640 by 480 pixels. Infant wide-field fundus photograph:
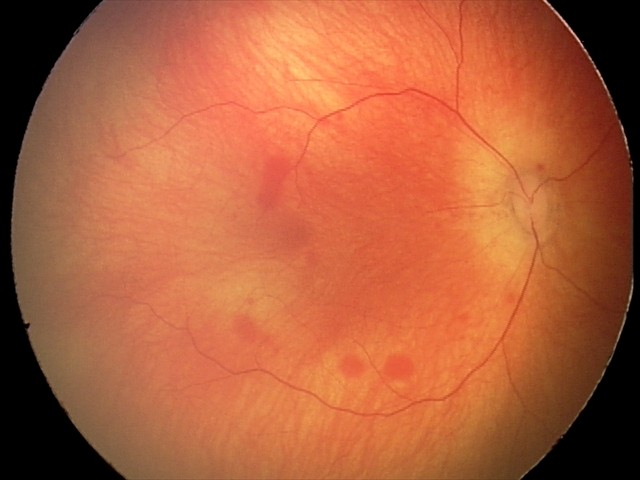

Q: What is the diagnosis from this examination?
A: retinal hemorrhages